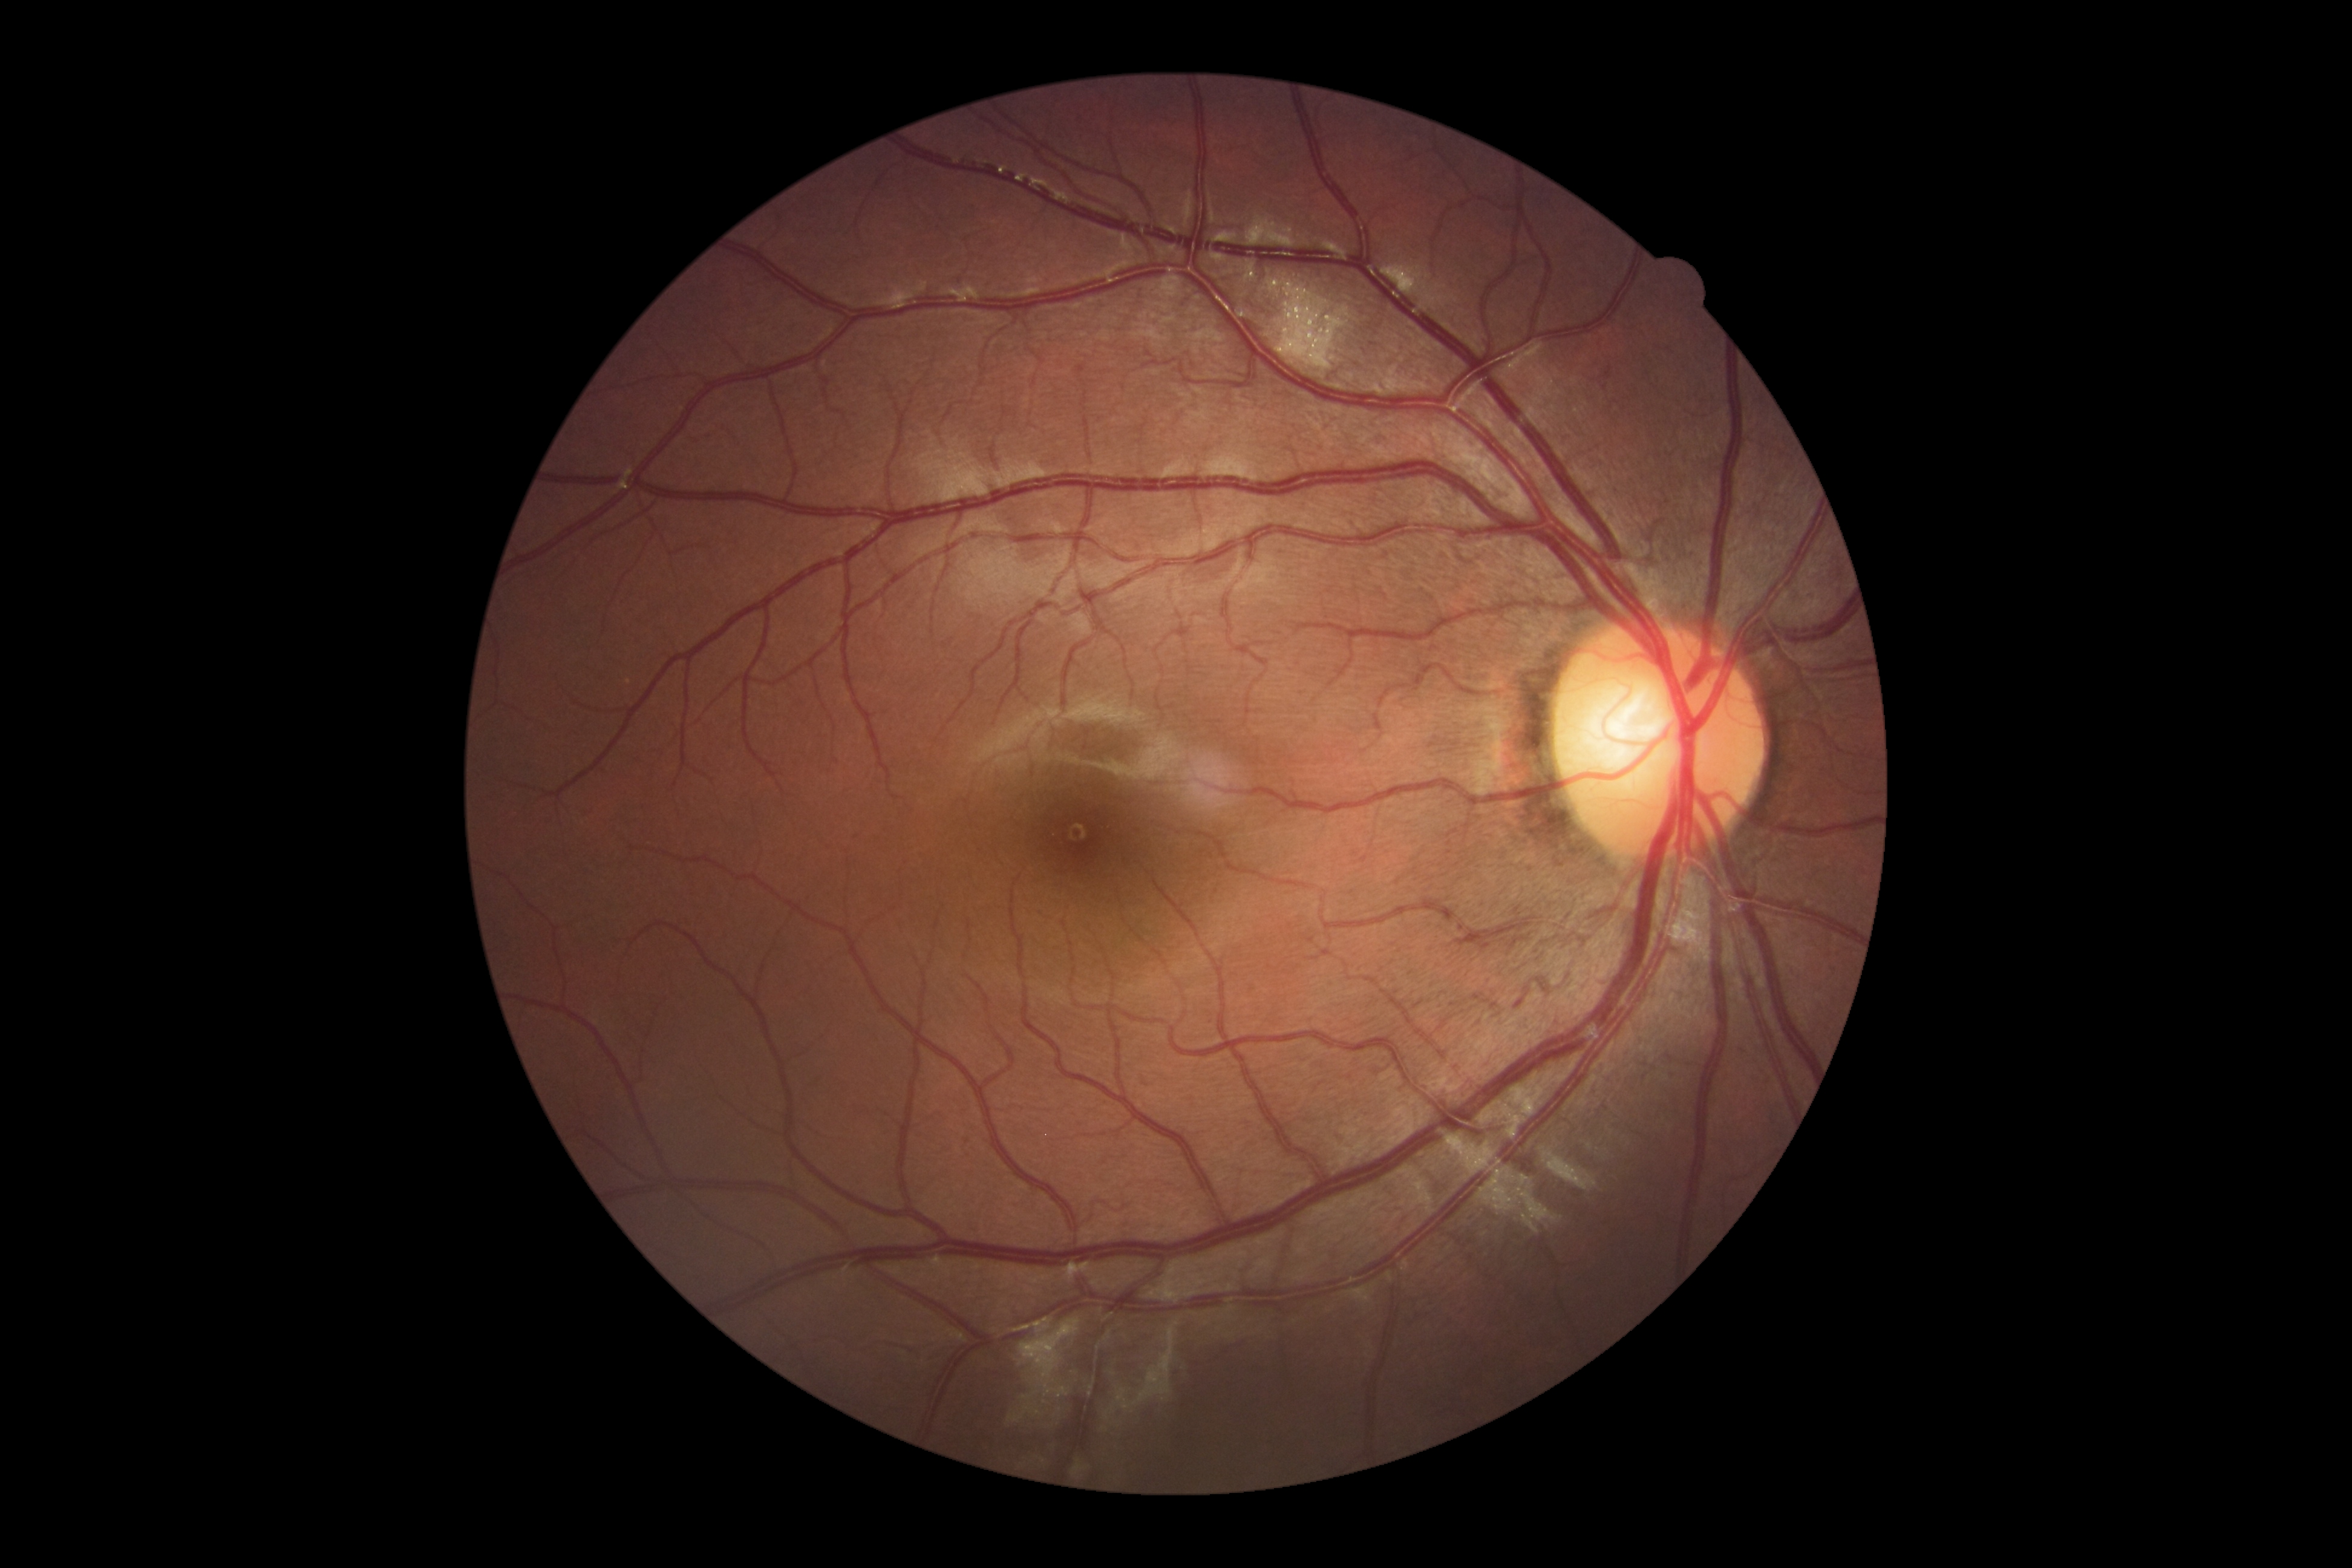 No diabetic retinal disease findings. DR severity: 0/4.